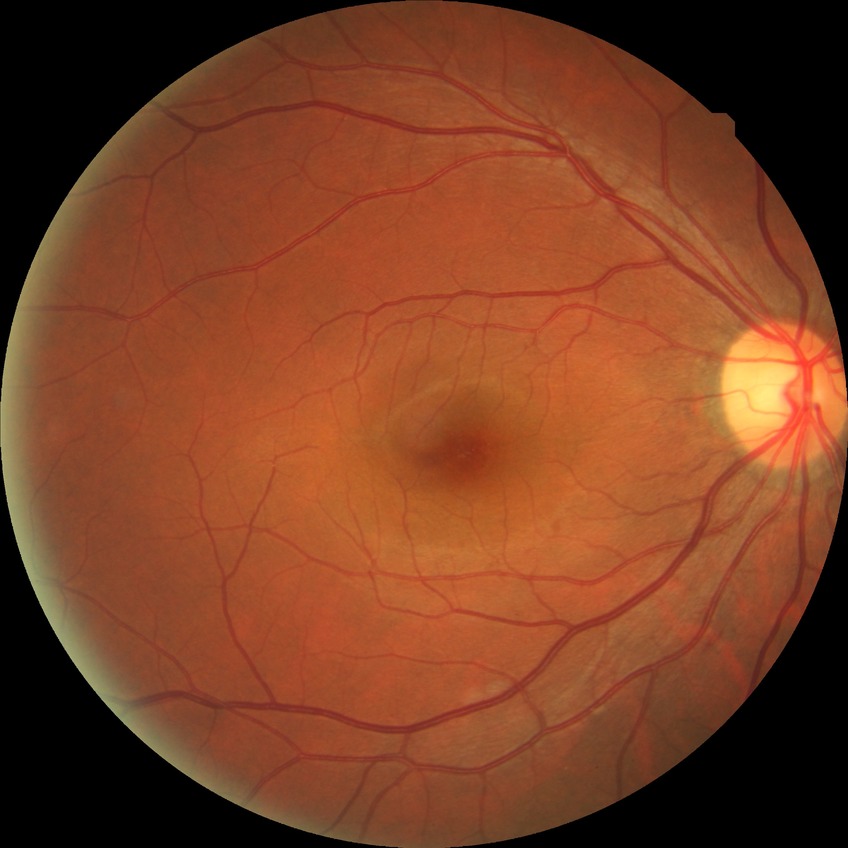
{"davis_grade": "simple diabetic retinopathy (SDR)", "proliferative_class": "non-proliferative diabetic retinopathy"}